Color fundus photograph:
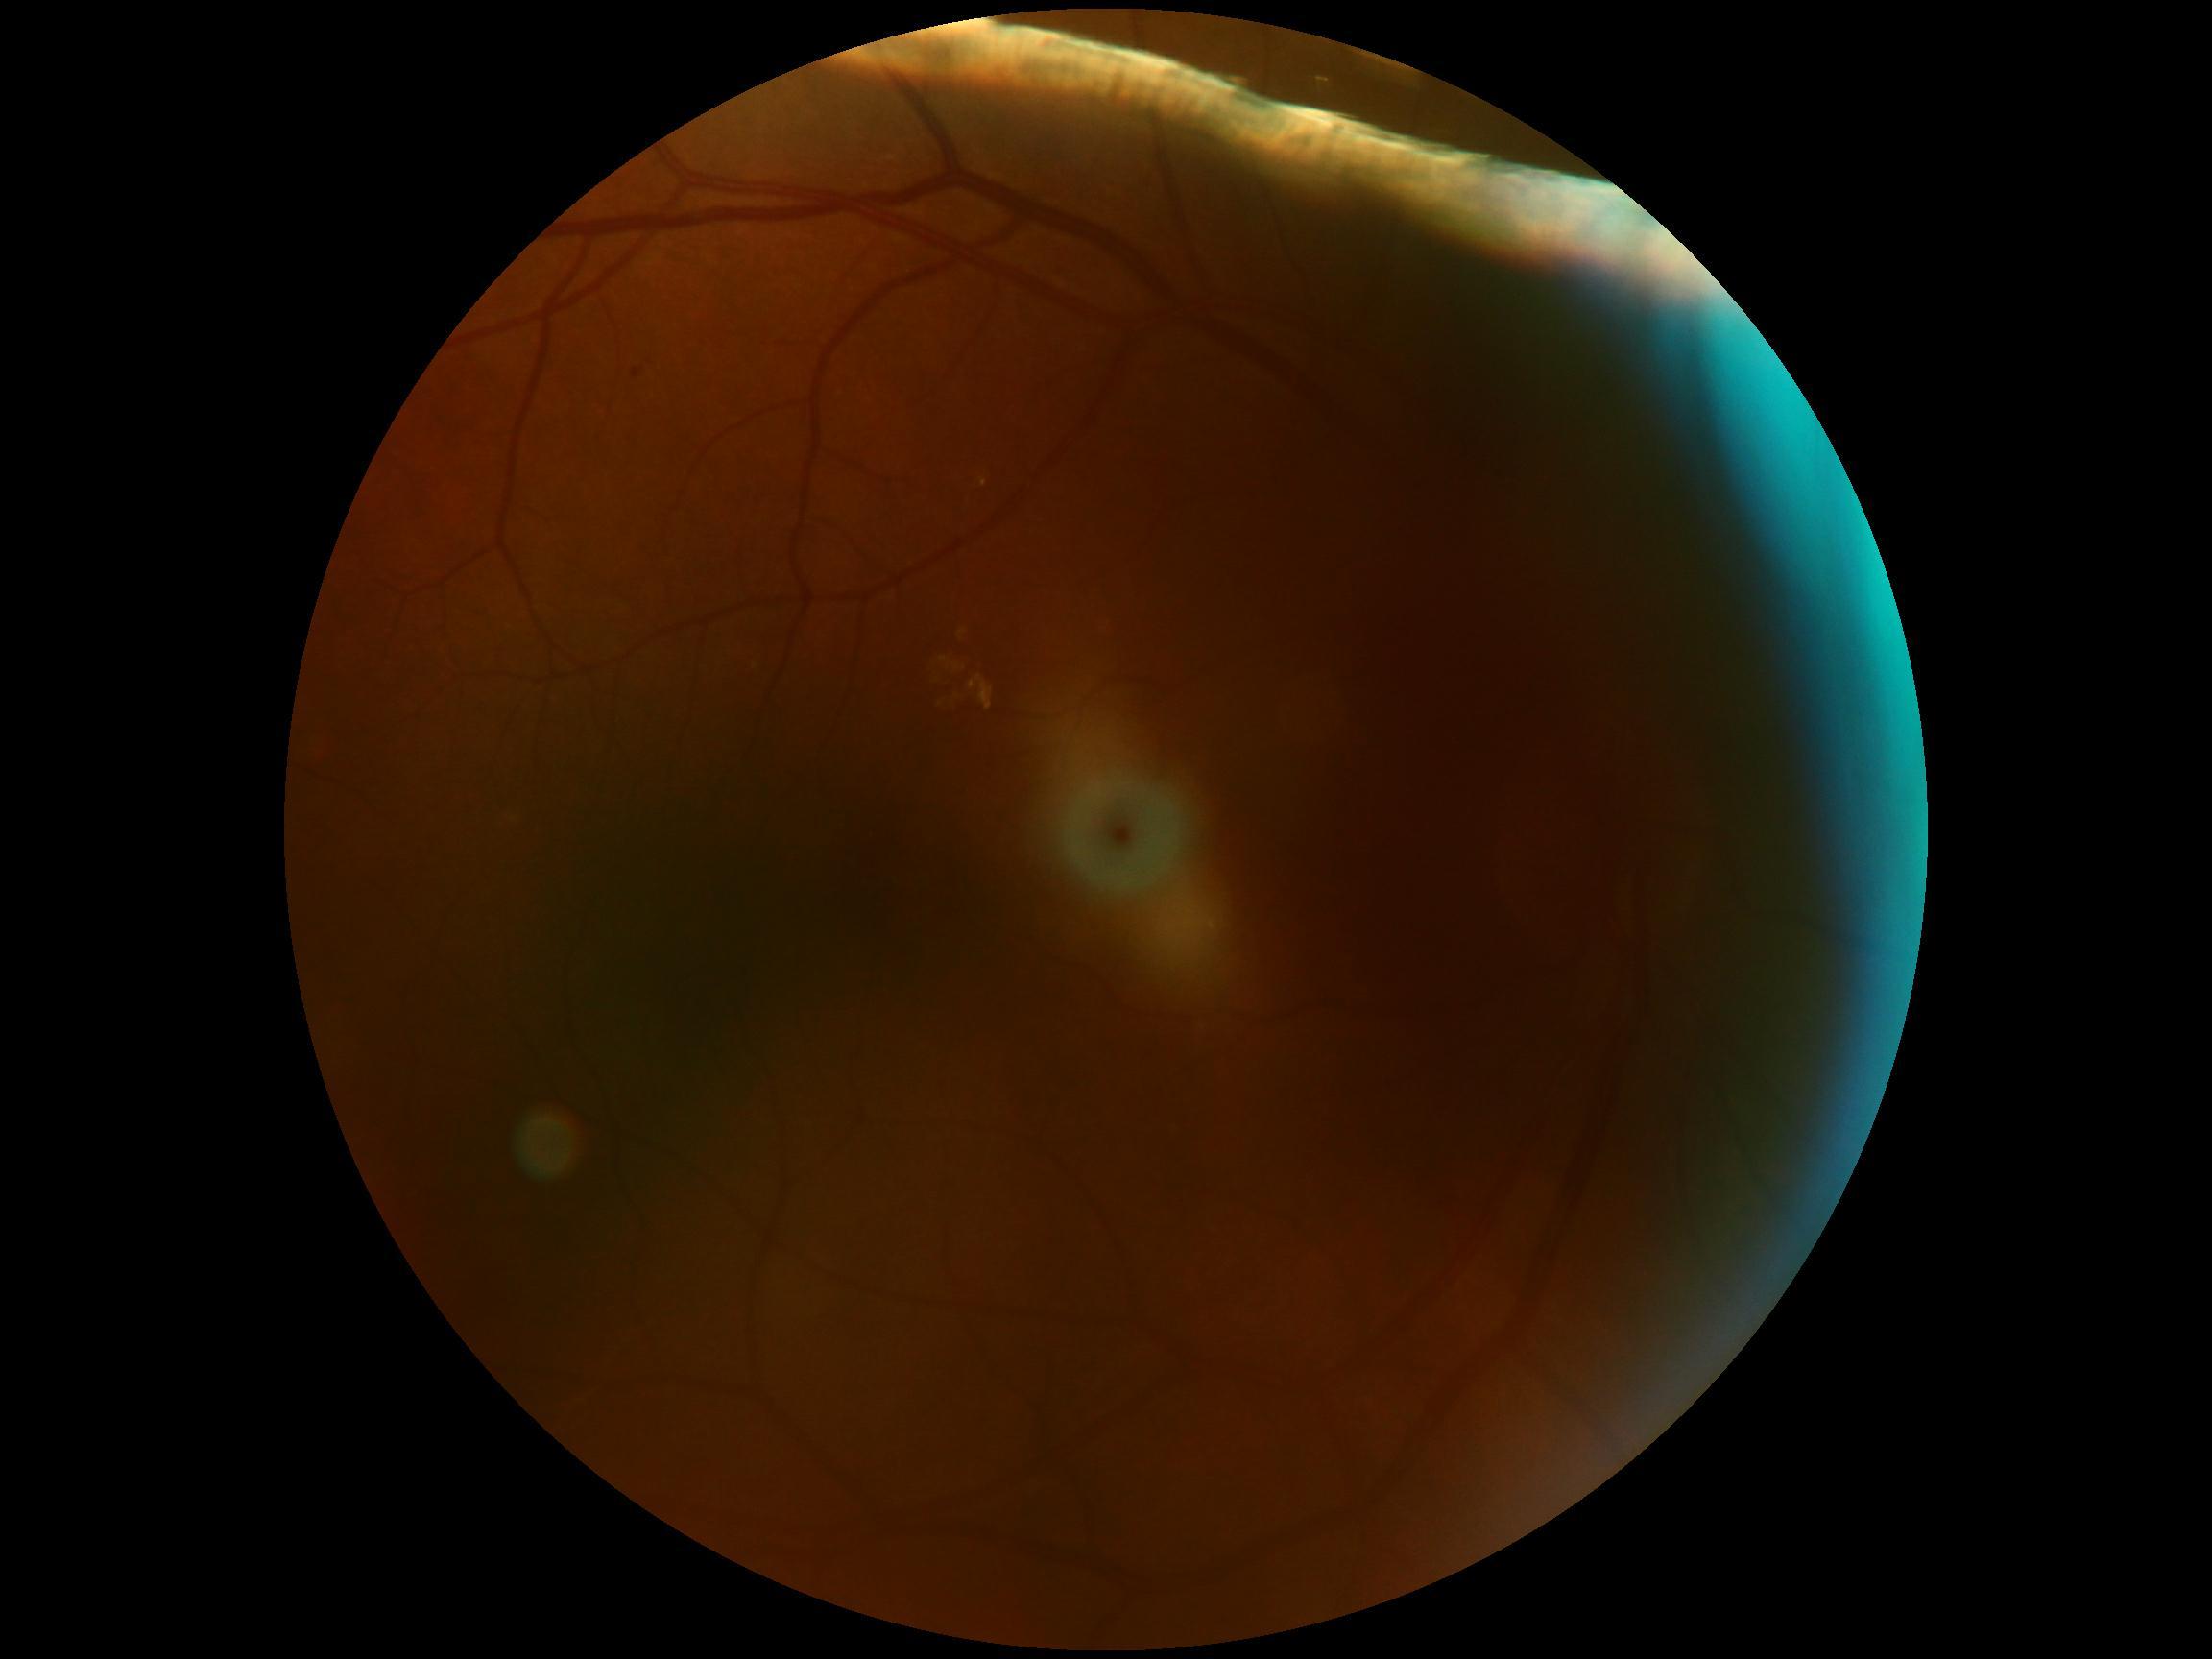
DR stage: moderate non-proliferative diabetic retinopathy (grade 2).